CFP, NIDEK AFC-230
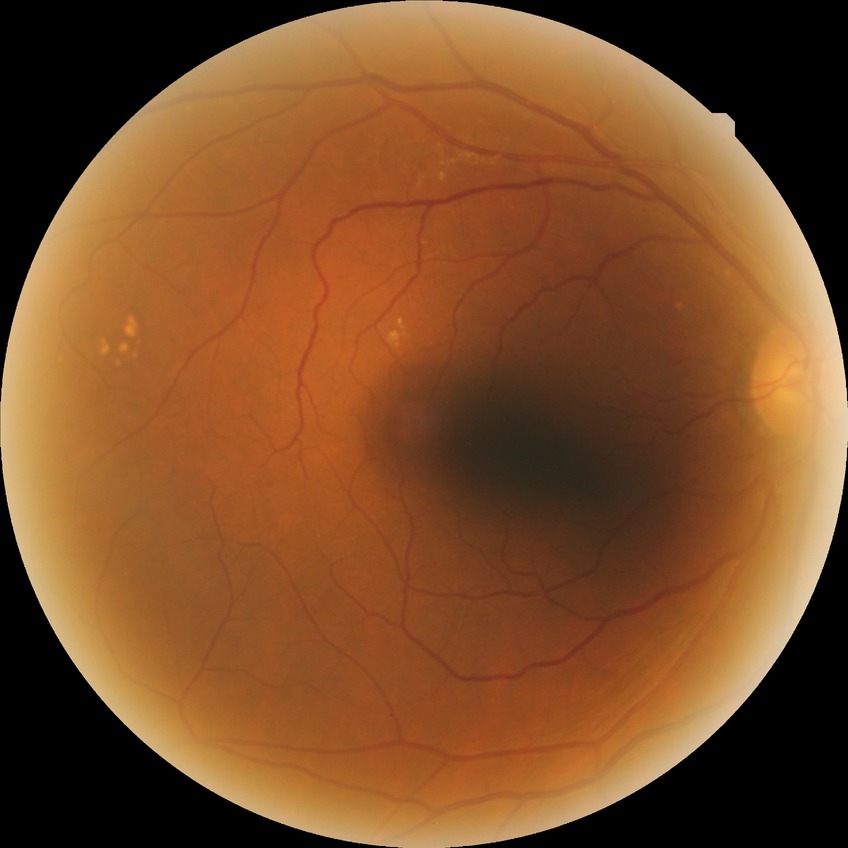 {
  "davis_grade": "NDR (no diabetic retinopathy)"
}